2352x1568: 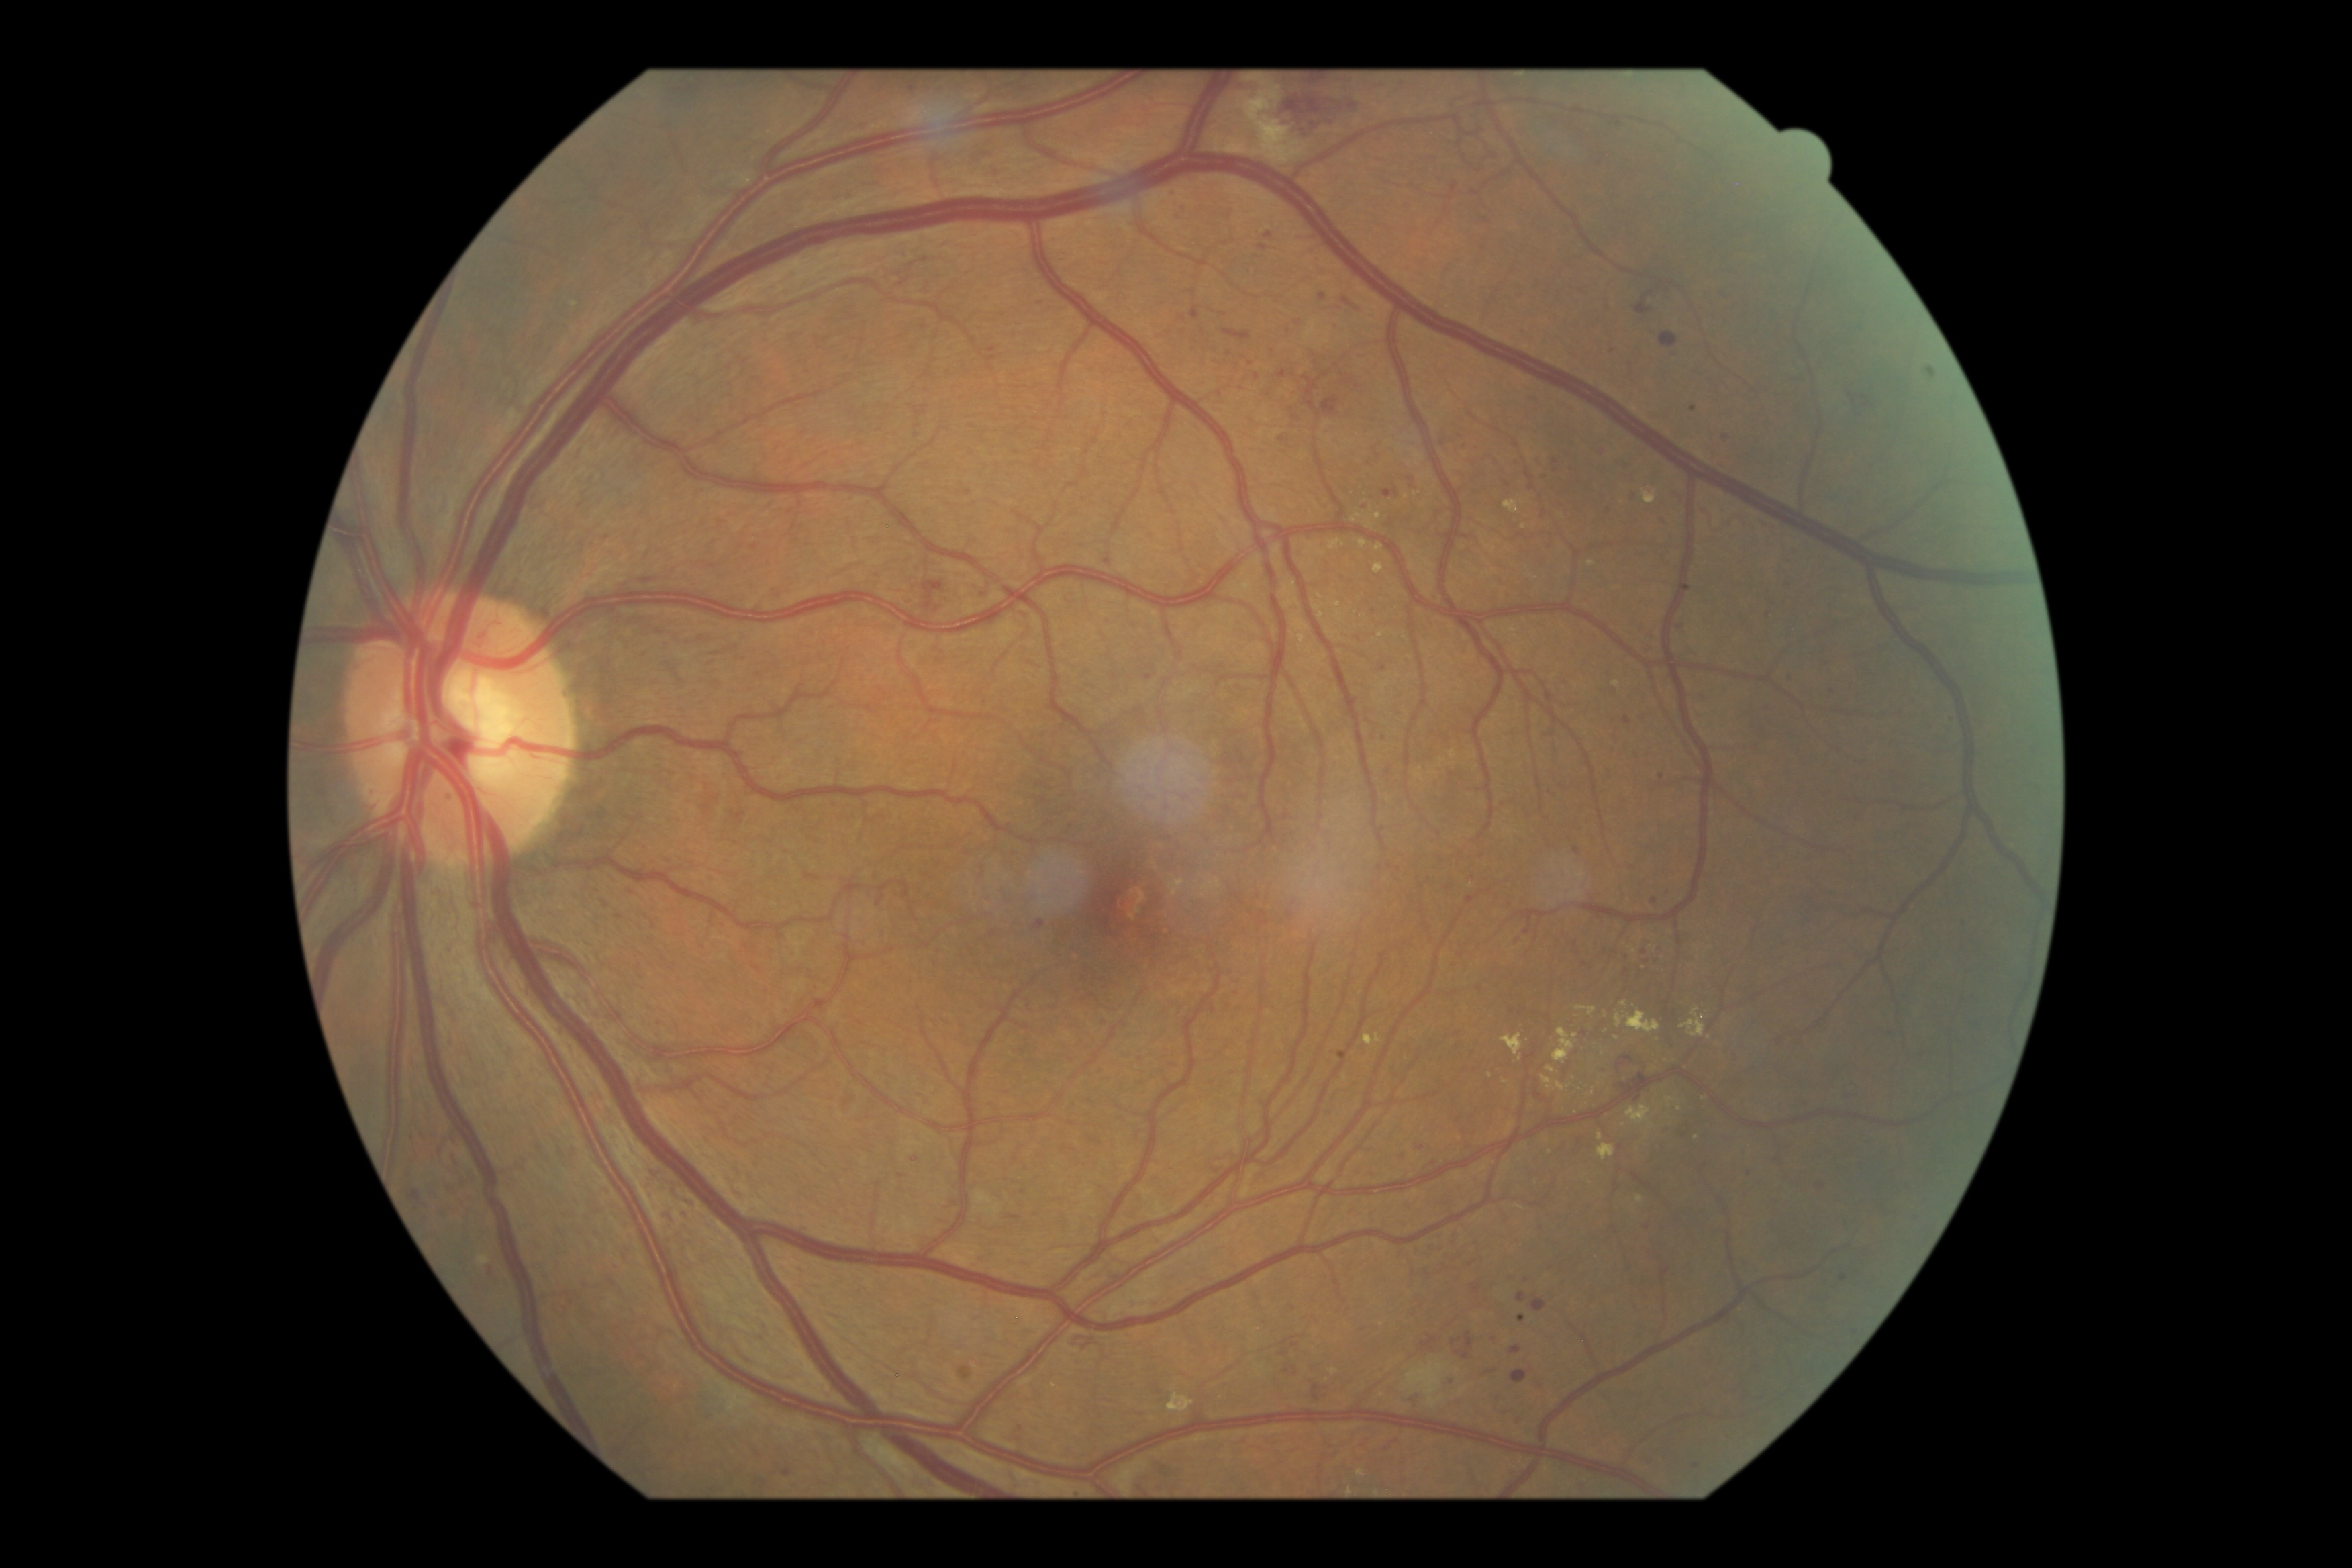

DR grade: 3 (severe NPDR)
Lesions identified (partial list):
* MAs (subset): 656, 1030, 663, 1041 | 1418, 1147, 1426, 1153 | 1841, 1275, 1848, 1283 | 1452, 183, 1459, 193 | 1279, 373, 1287, 379 | 1778, 1037, 1787, 1048 | 663, 1210, 668, 1218
* Additional small MAs near 1242, 389 | 1104, 1023 | 1288, 1372 | 993, 349 | 1391, 867 | 1556, 462 | 1272, 349 | 1643, 556 | 1662, 778 | 1022, 1427 | 1963, 923